Infant wide-field fundus photograph. 130° field of view (Clarity RetCam 3): 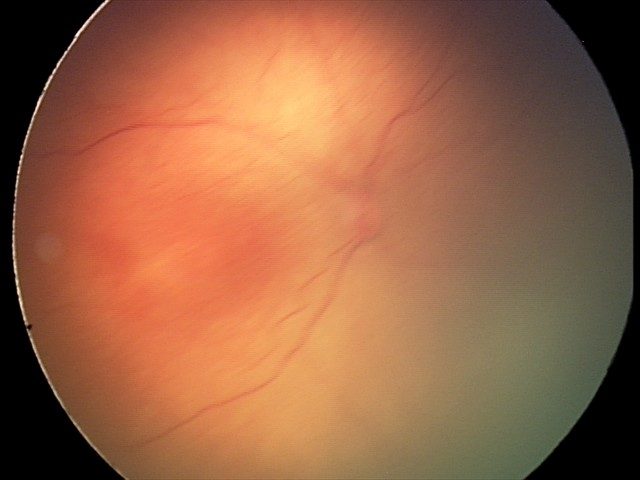

Screening diagnosis = ROP stage 2
plus disease = absent — posterior pole vessels without abnormal dilation or tortuosity